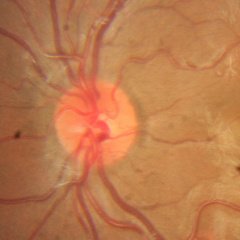 No glaucomatous changes.